FOV: 45 degrees. Color fundus image. Image size 2212x1659 — 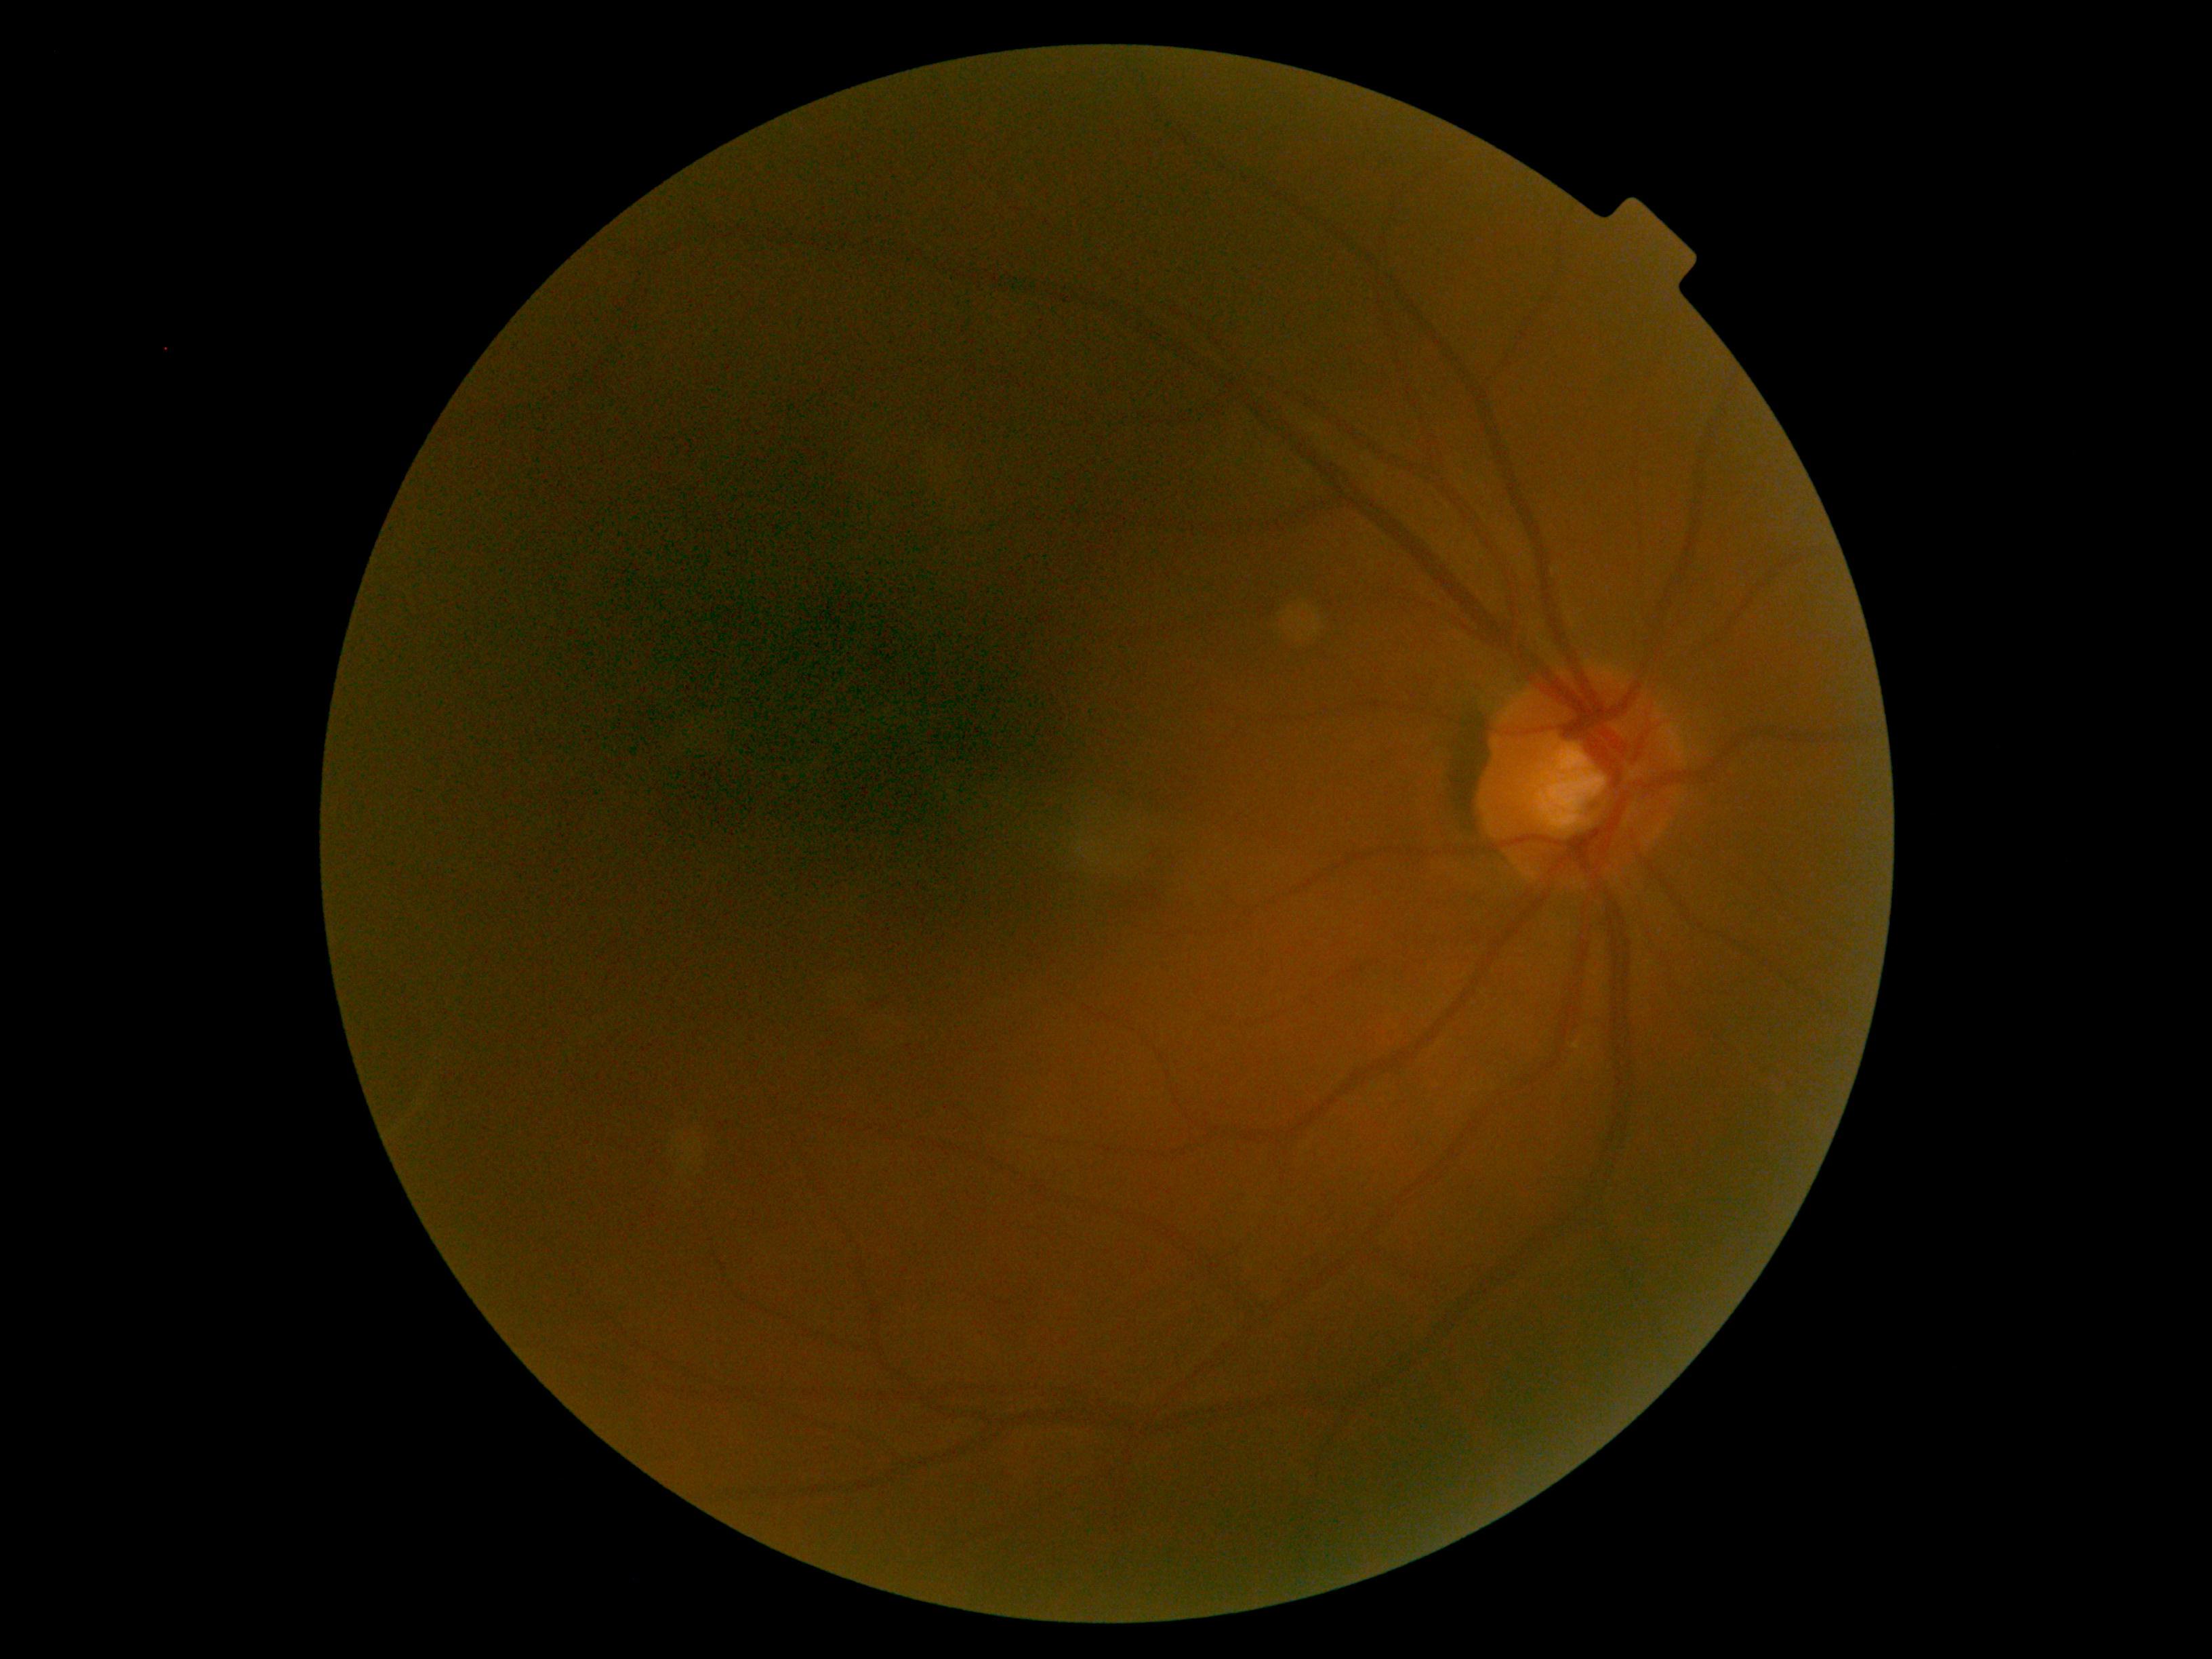
{"dr_grade": "0", "dr_impression": "no apparent DR"}